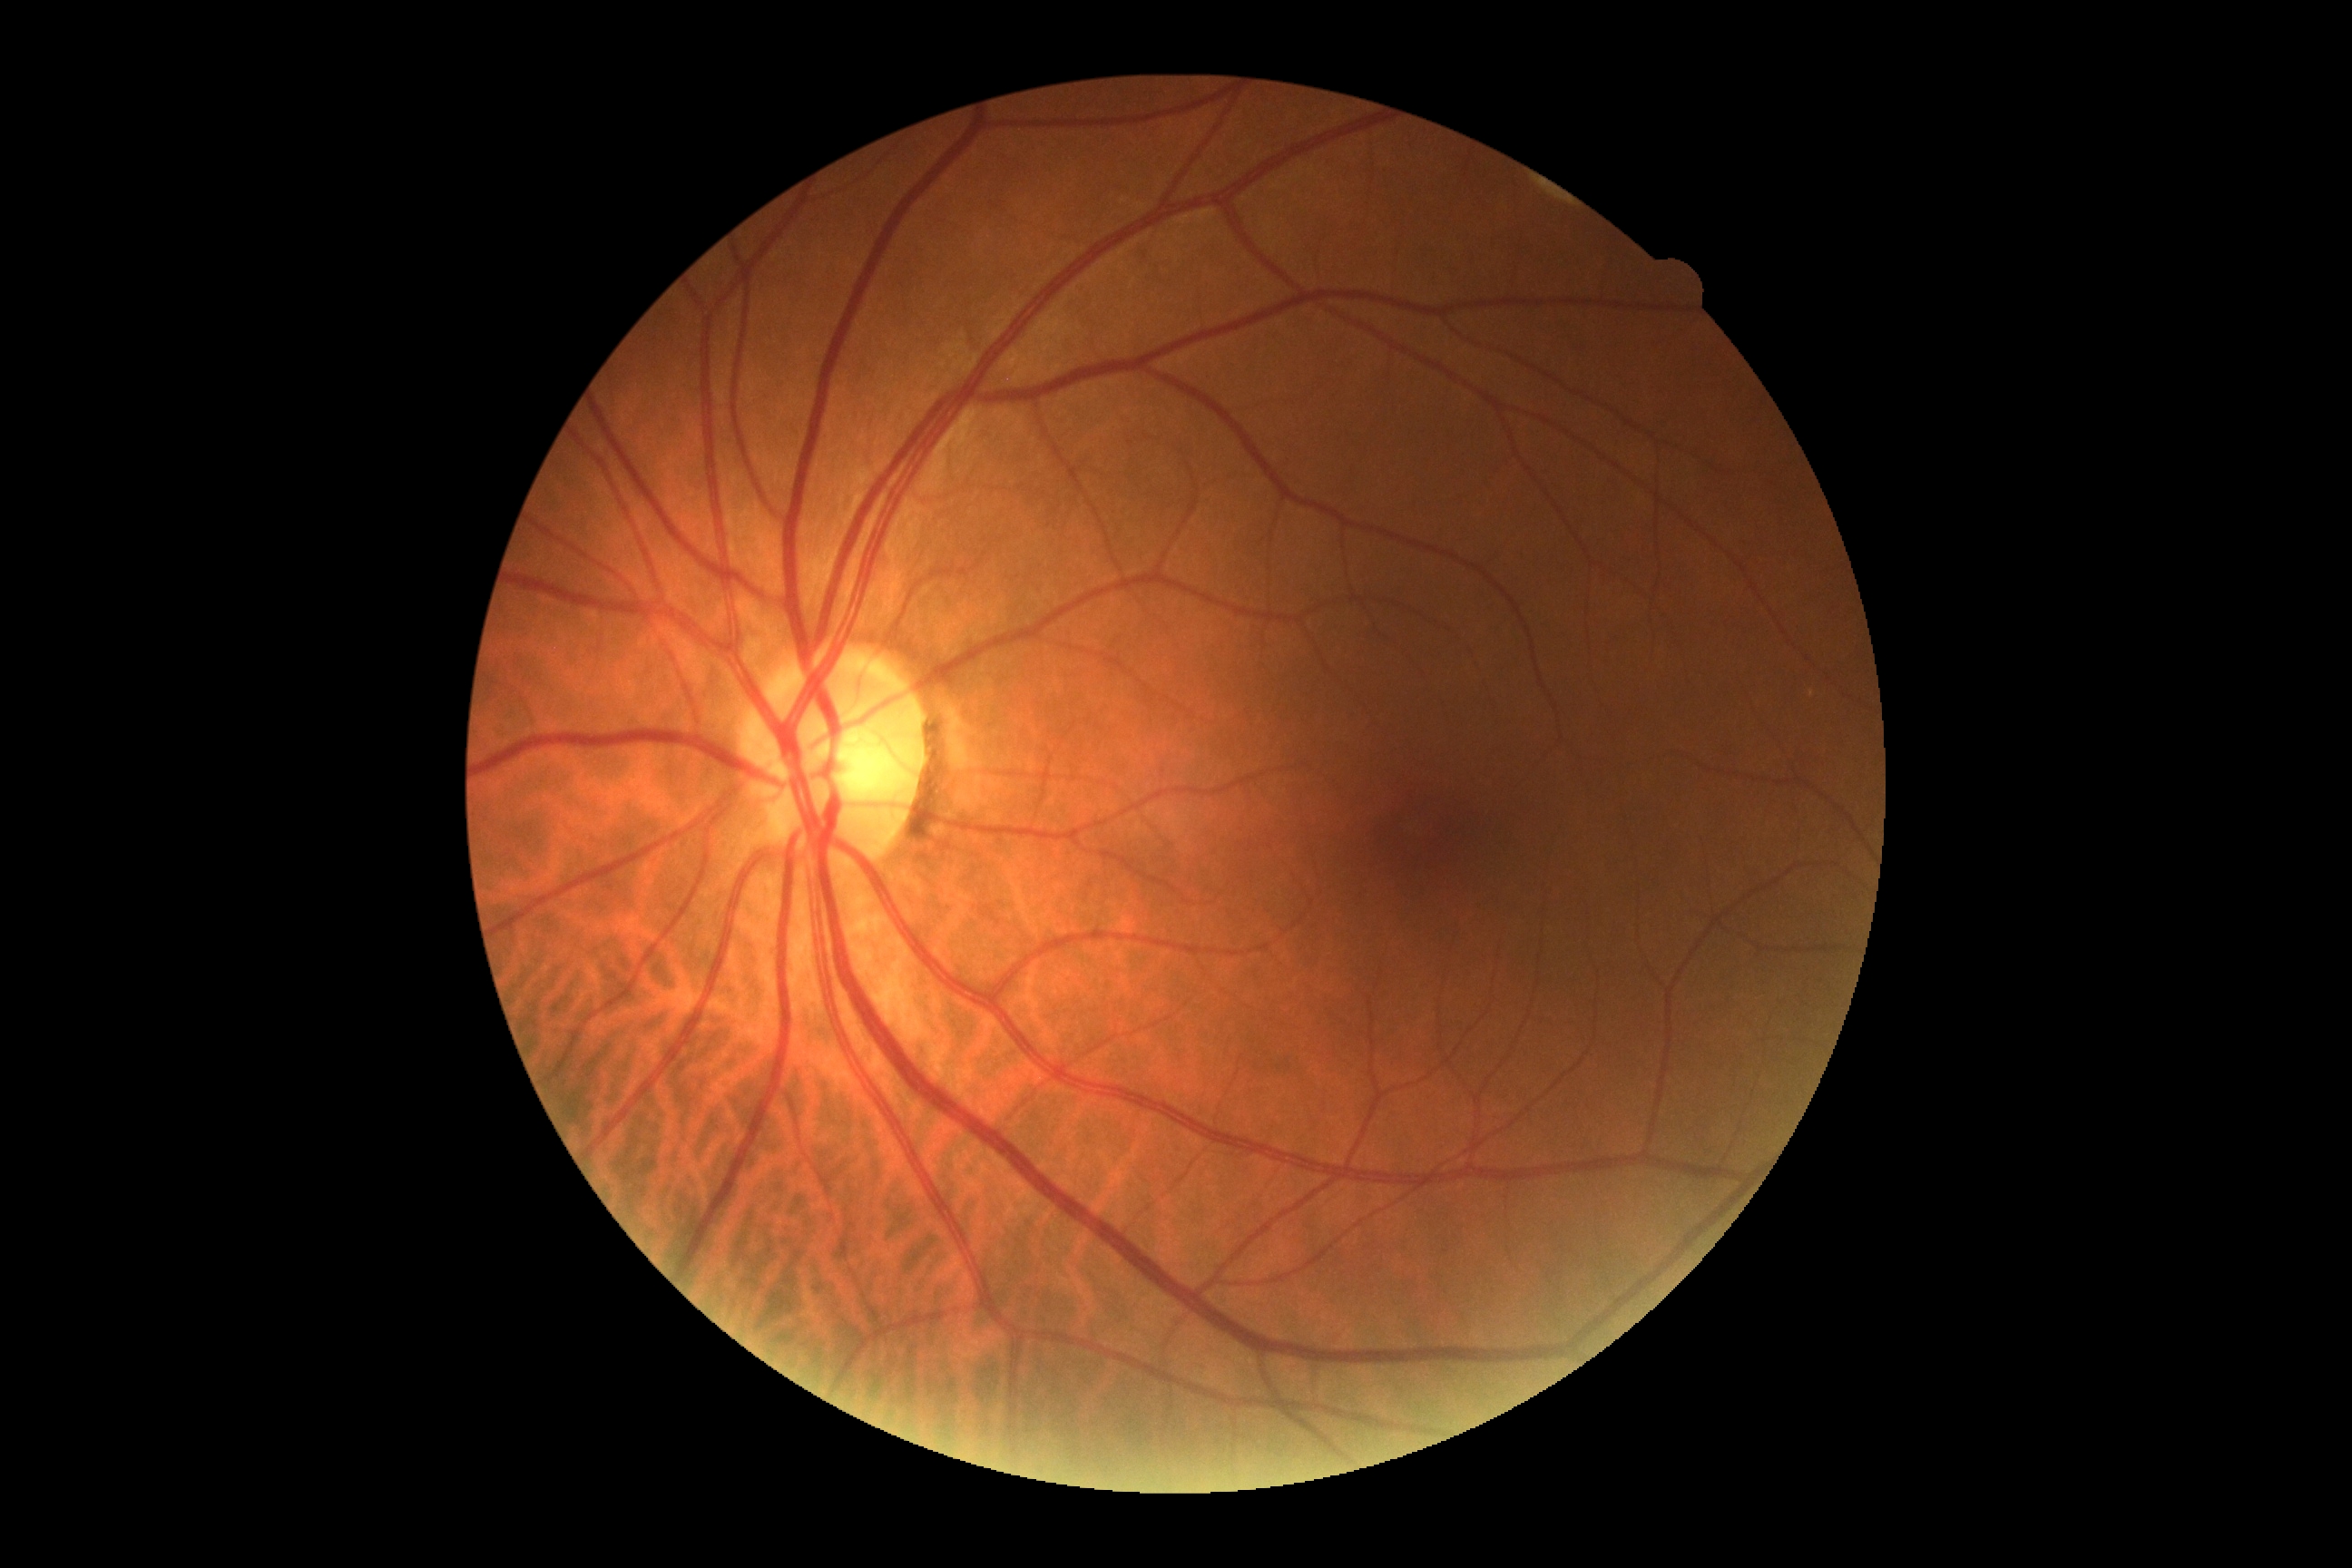

diabetic retinopathy: grade 0 (no apparent retinopathy)